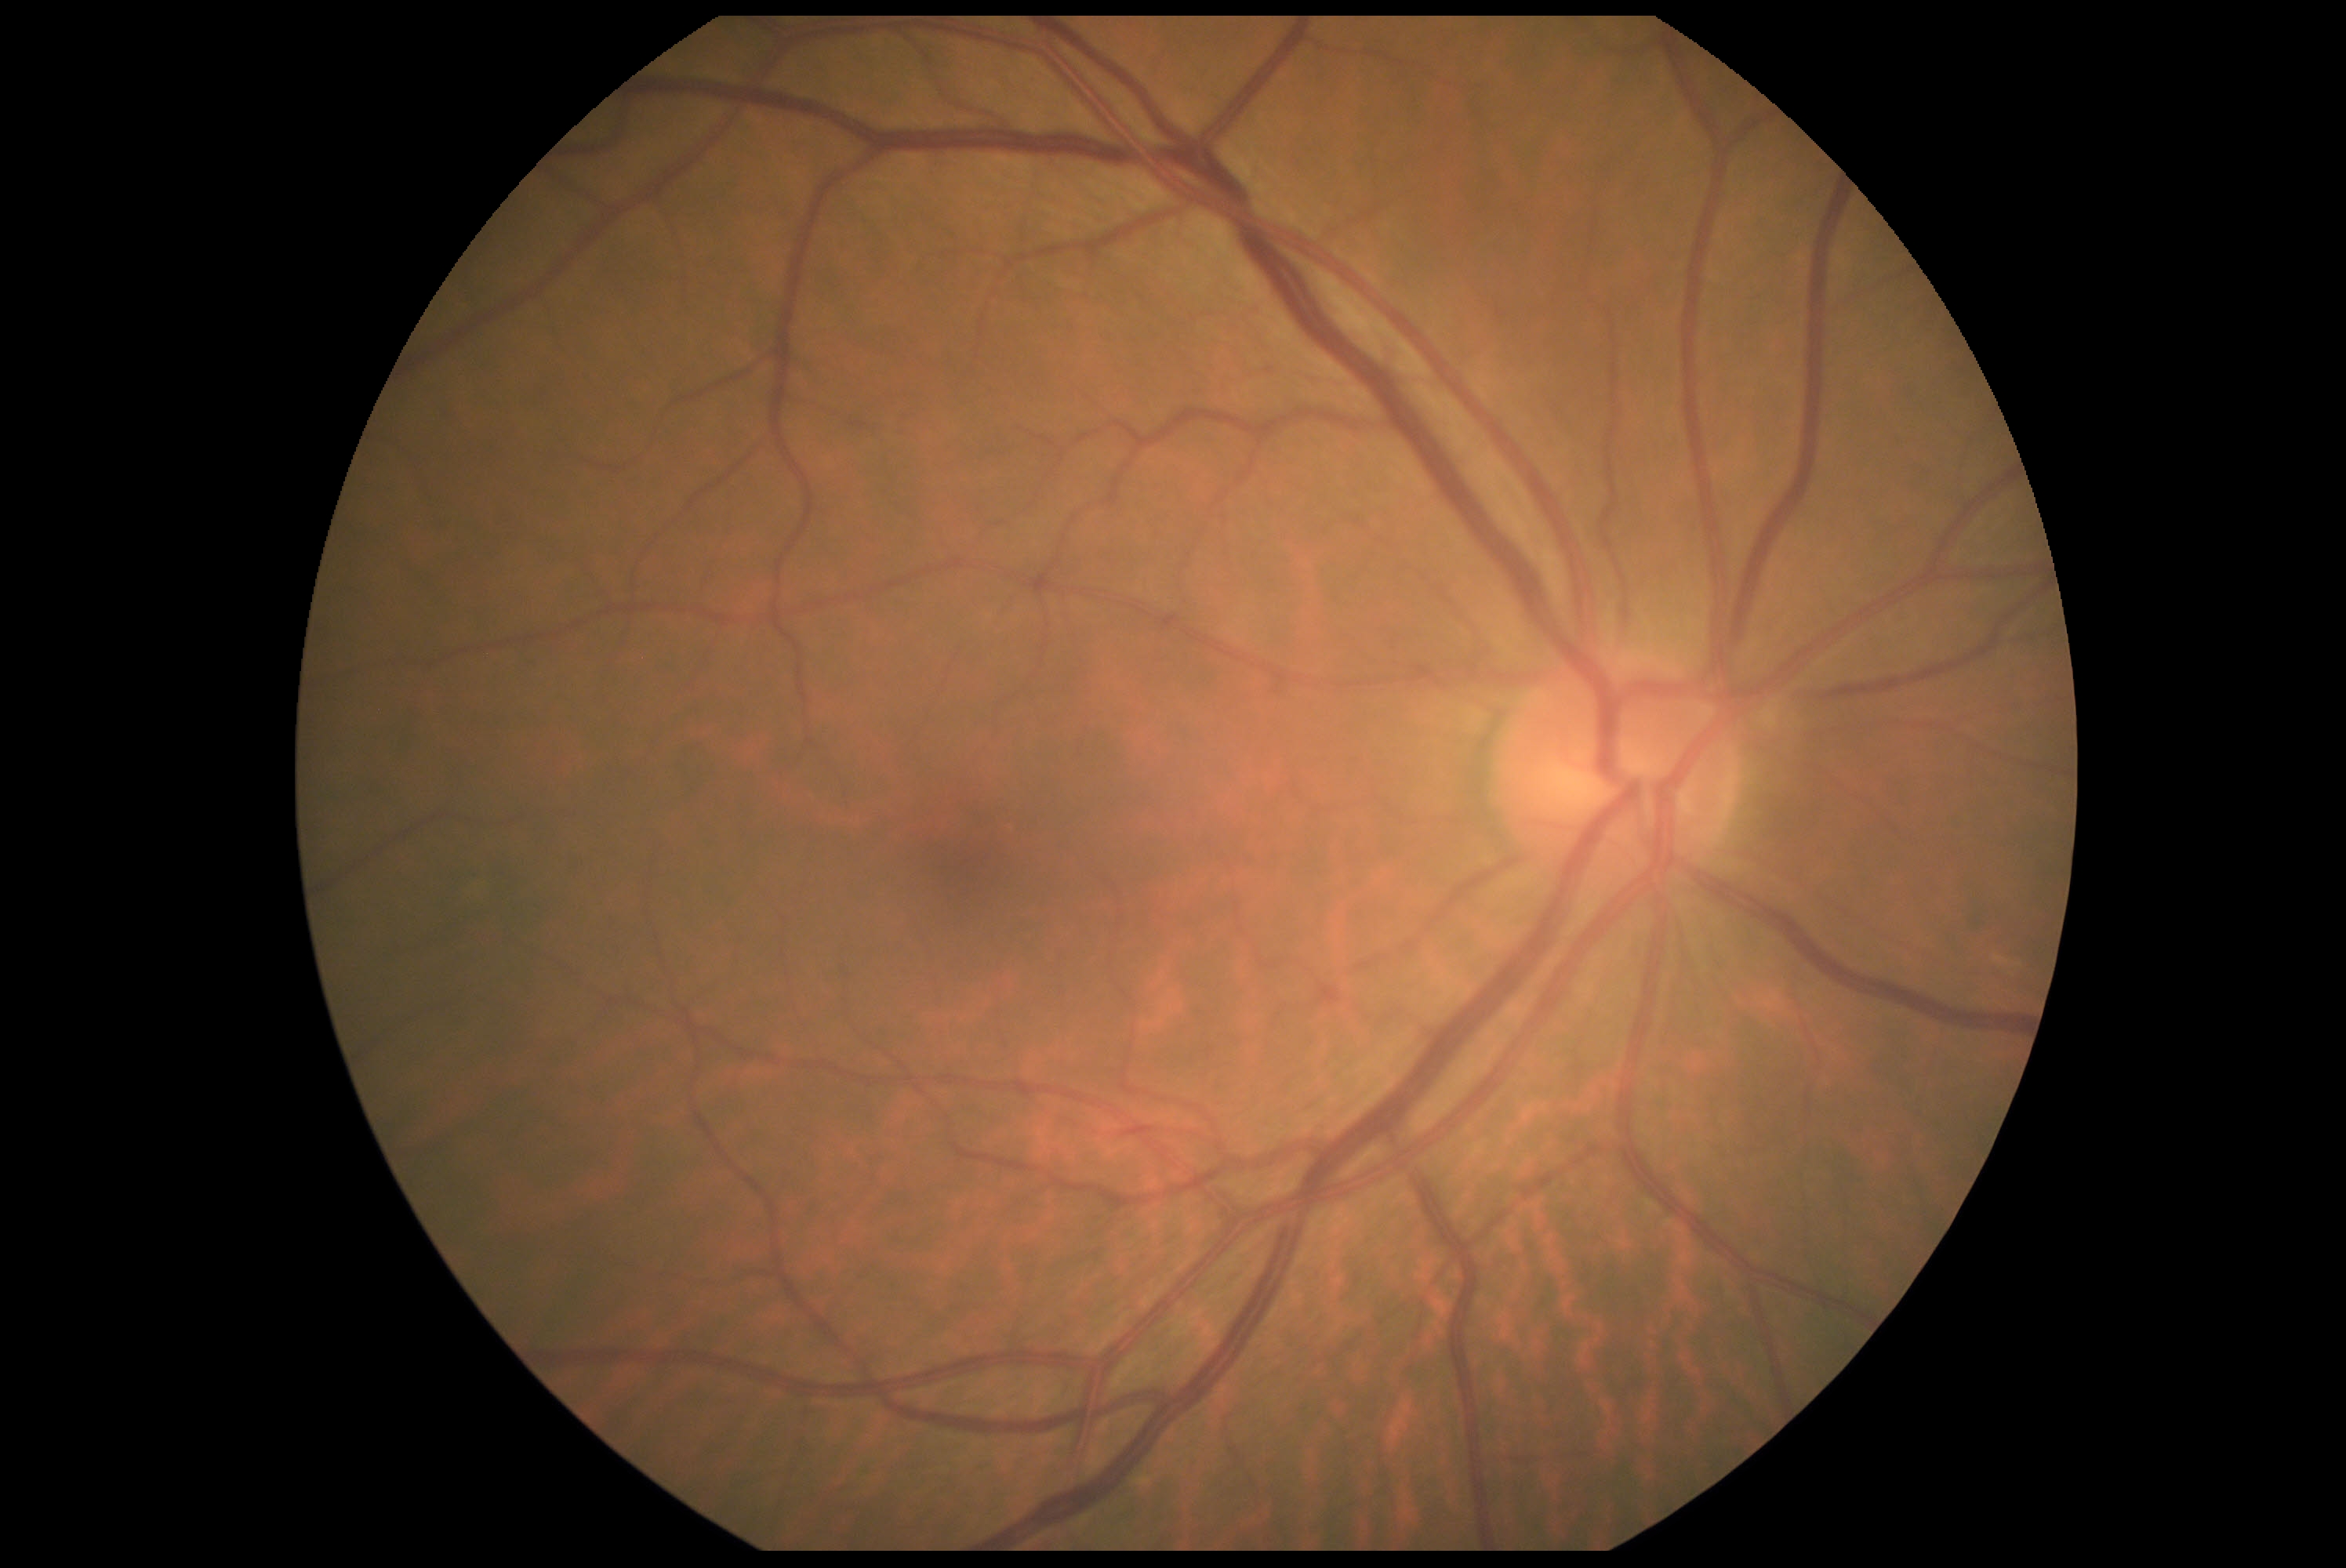

DR grade: no apparent retinopathy (0).